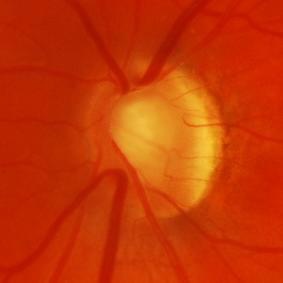
Glaucoma assessment = evidence of glaucoma.